1960x1897. Retinal fundus photograph. 45° field of view
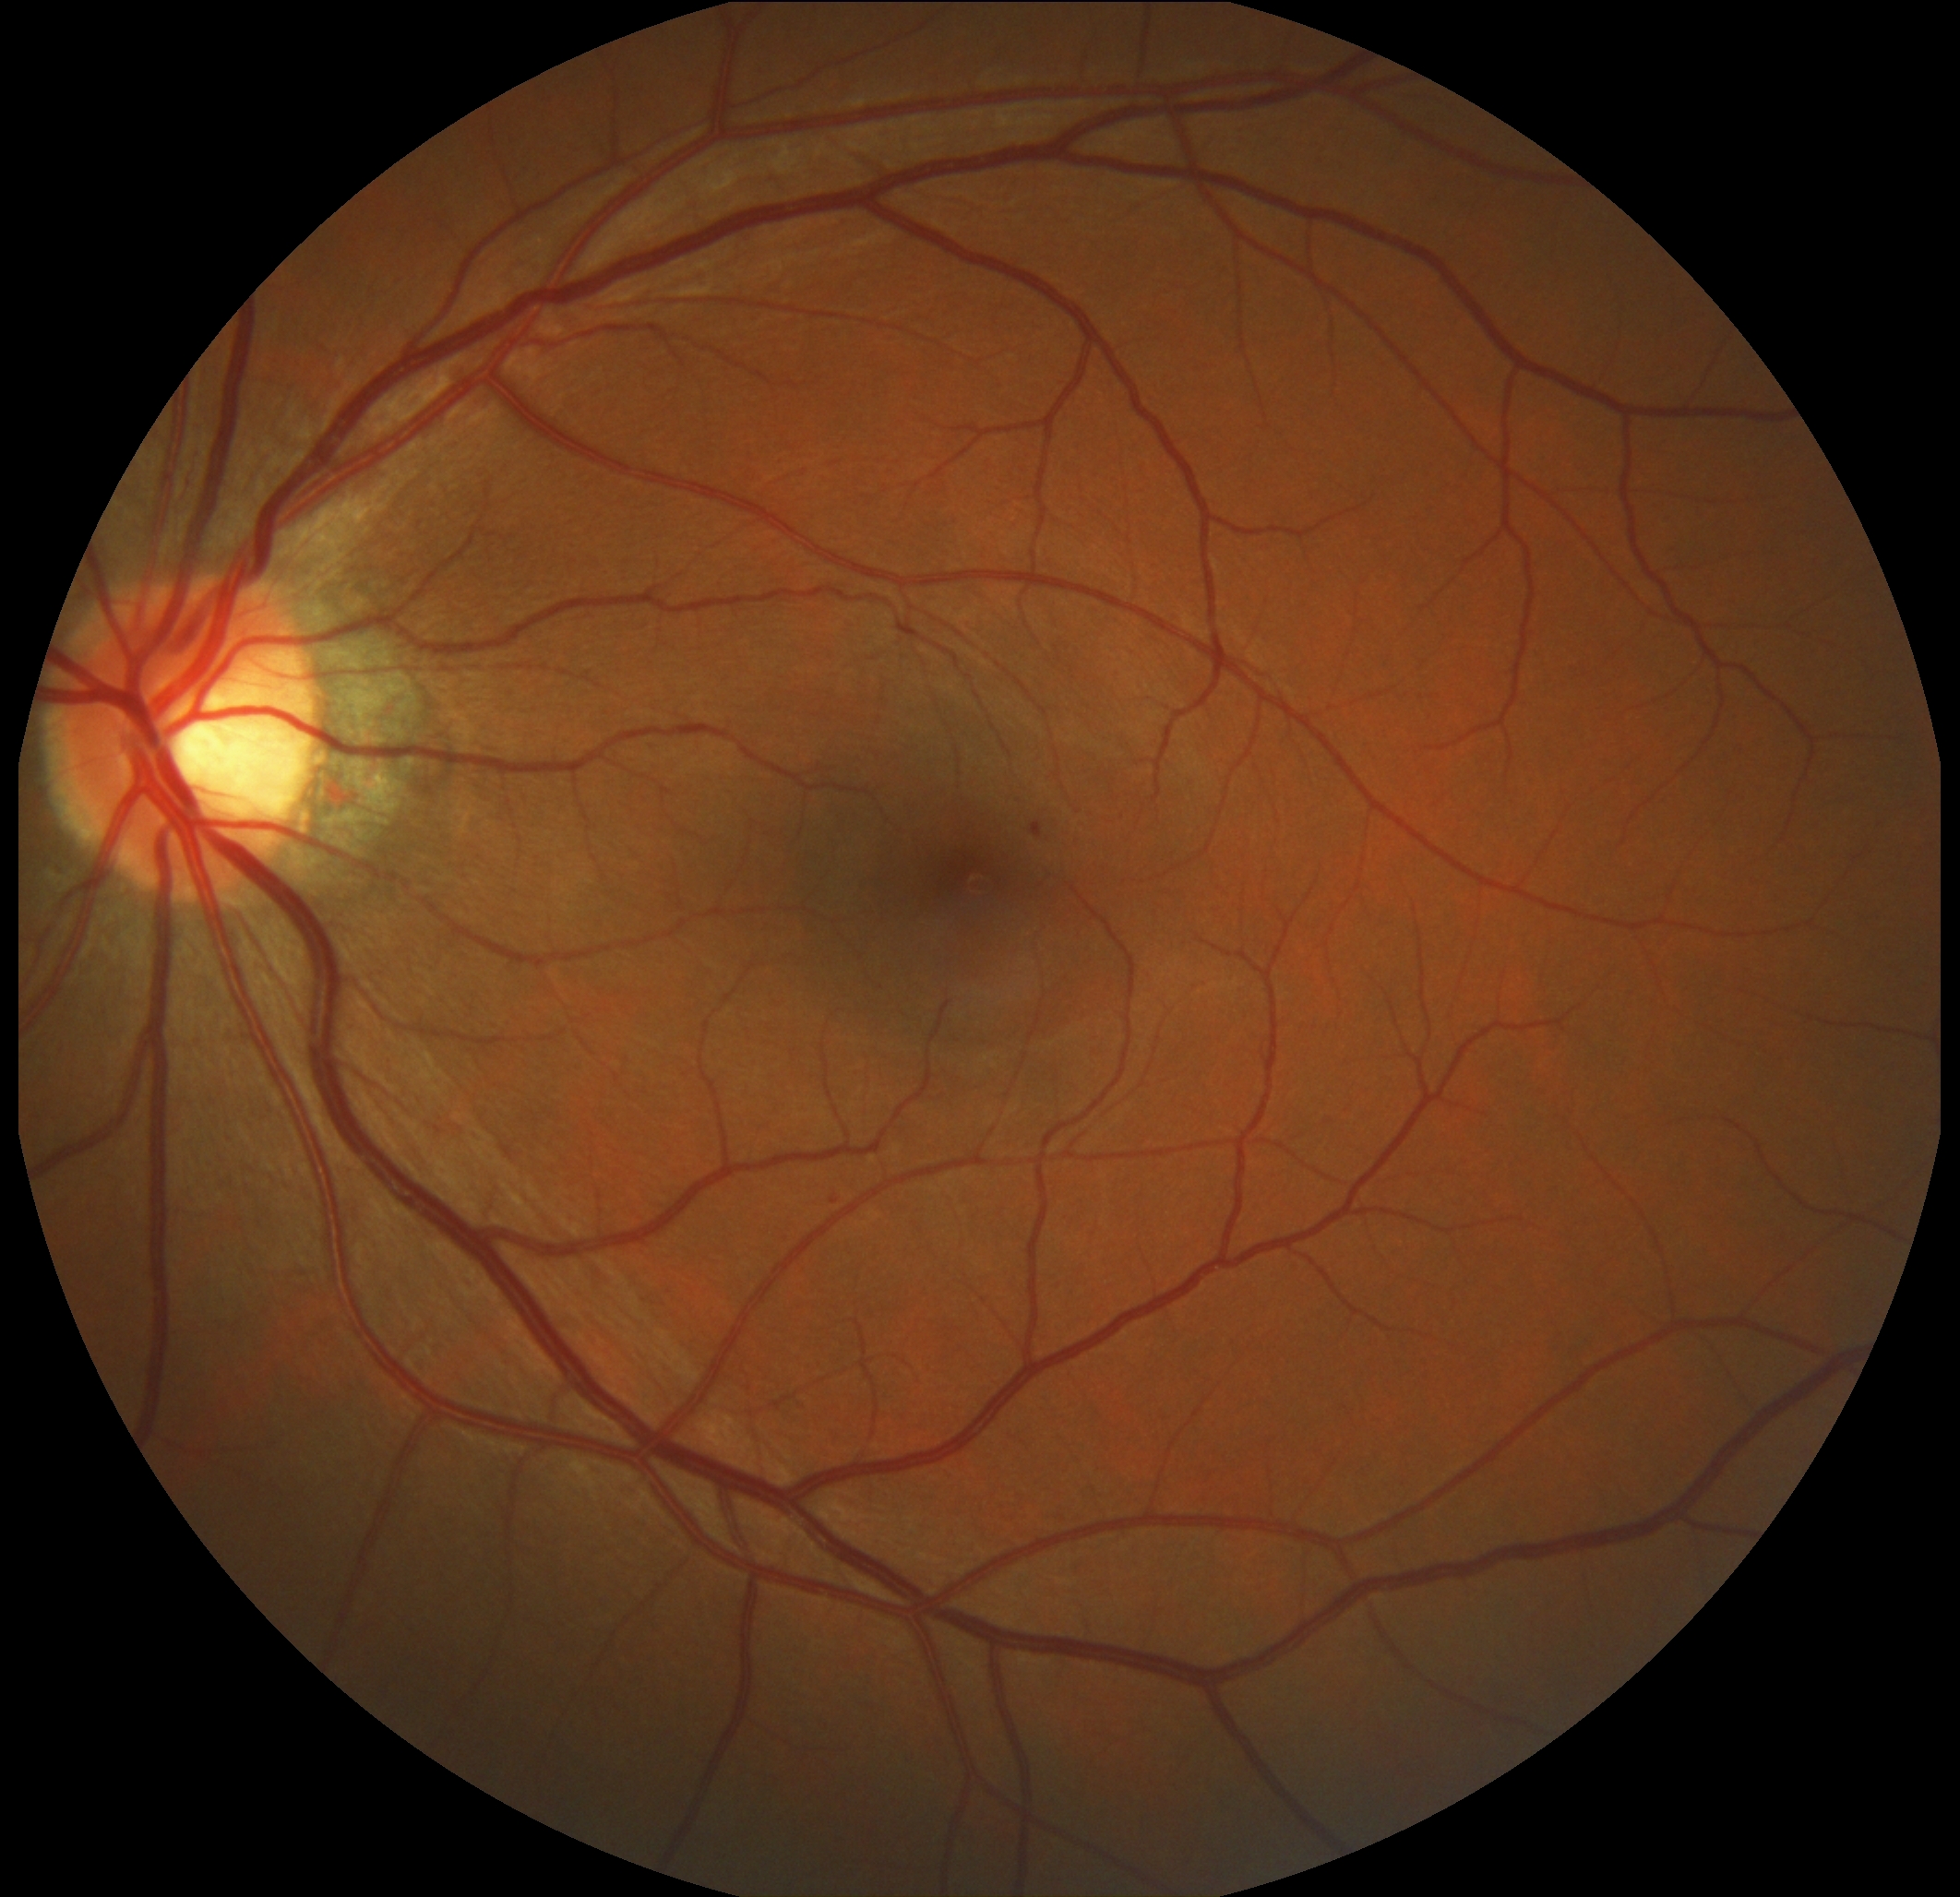

DR is grade 1 (mild NPDR).